45-degree field of view · color fundus image · 2352 x 1568 pixels: 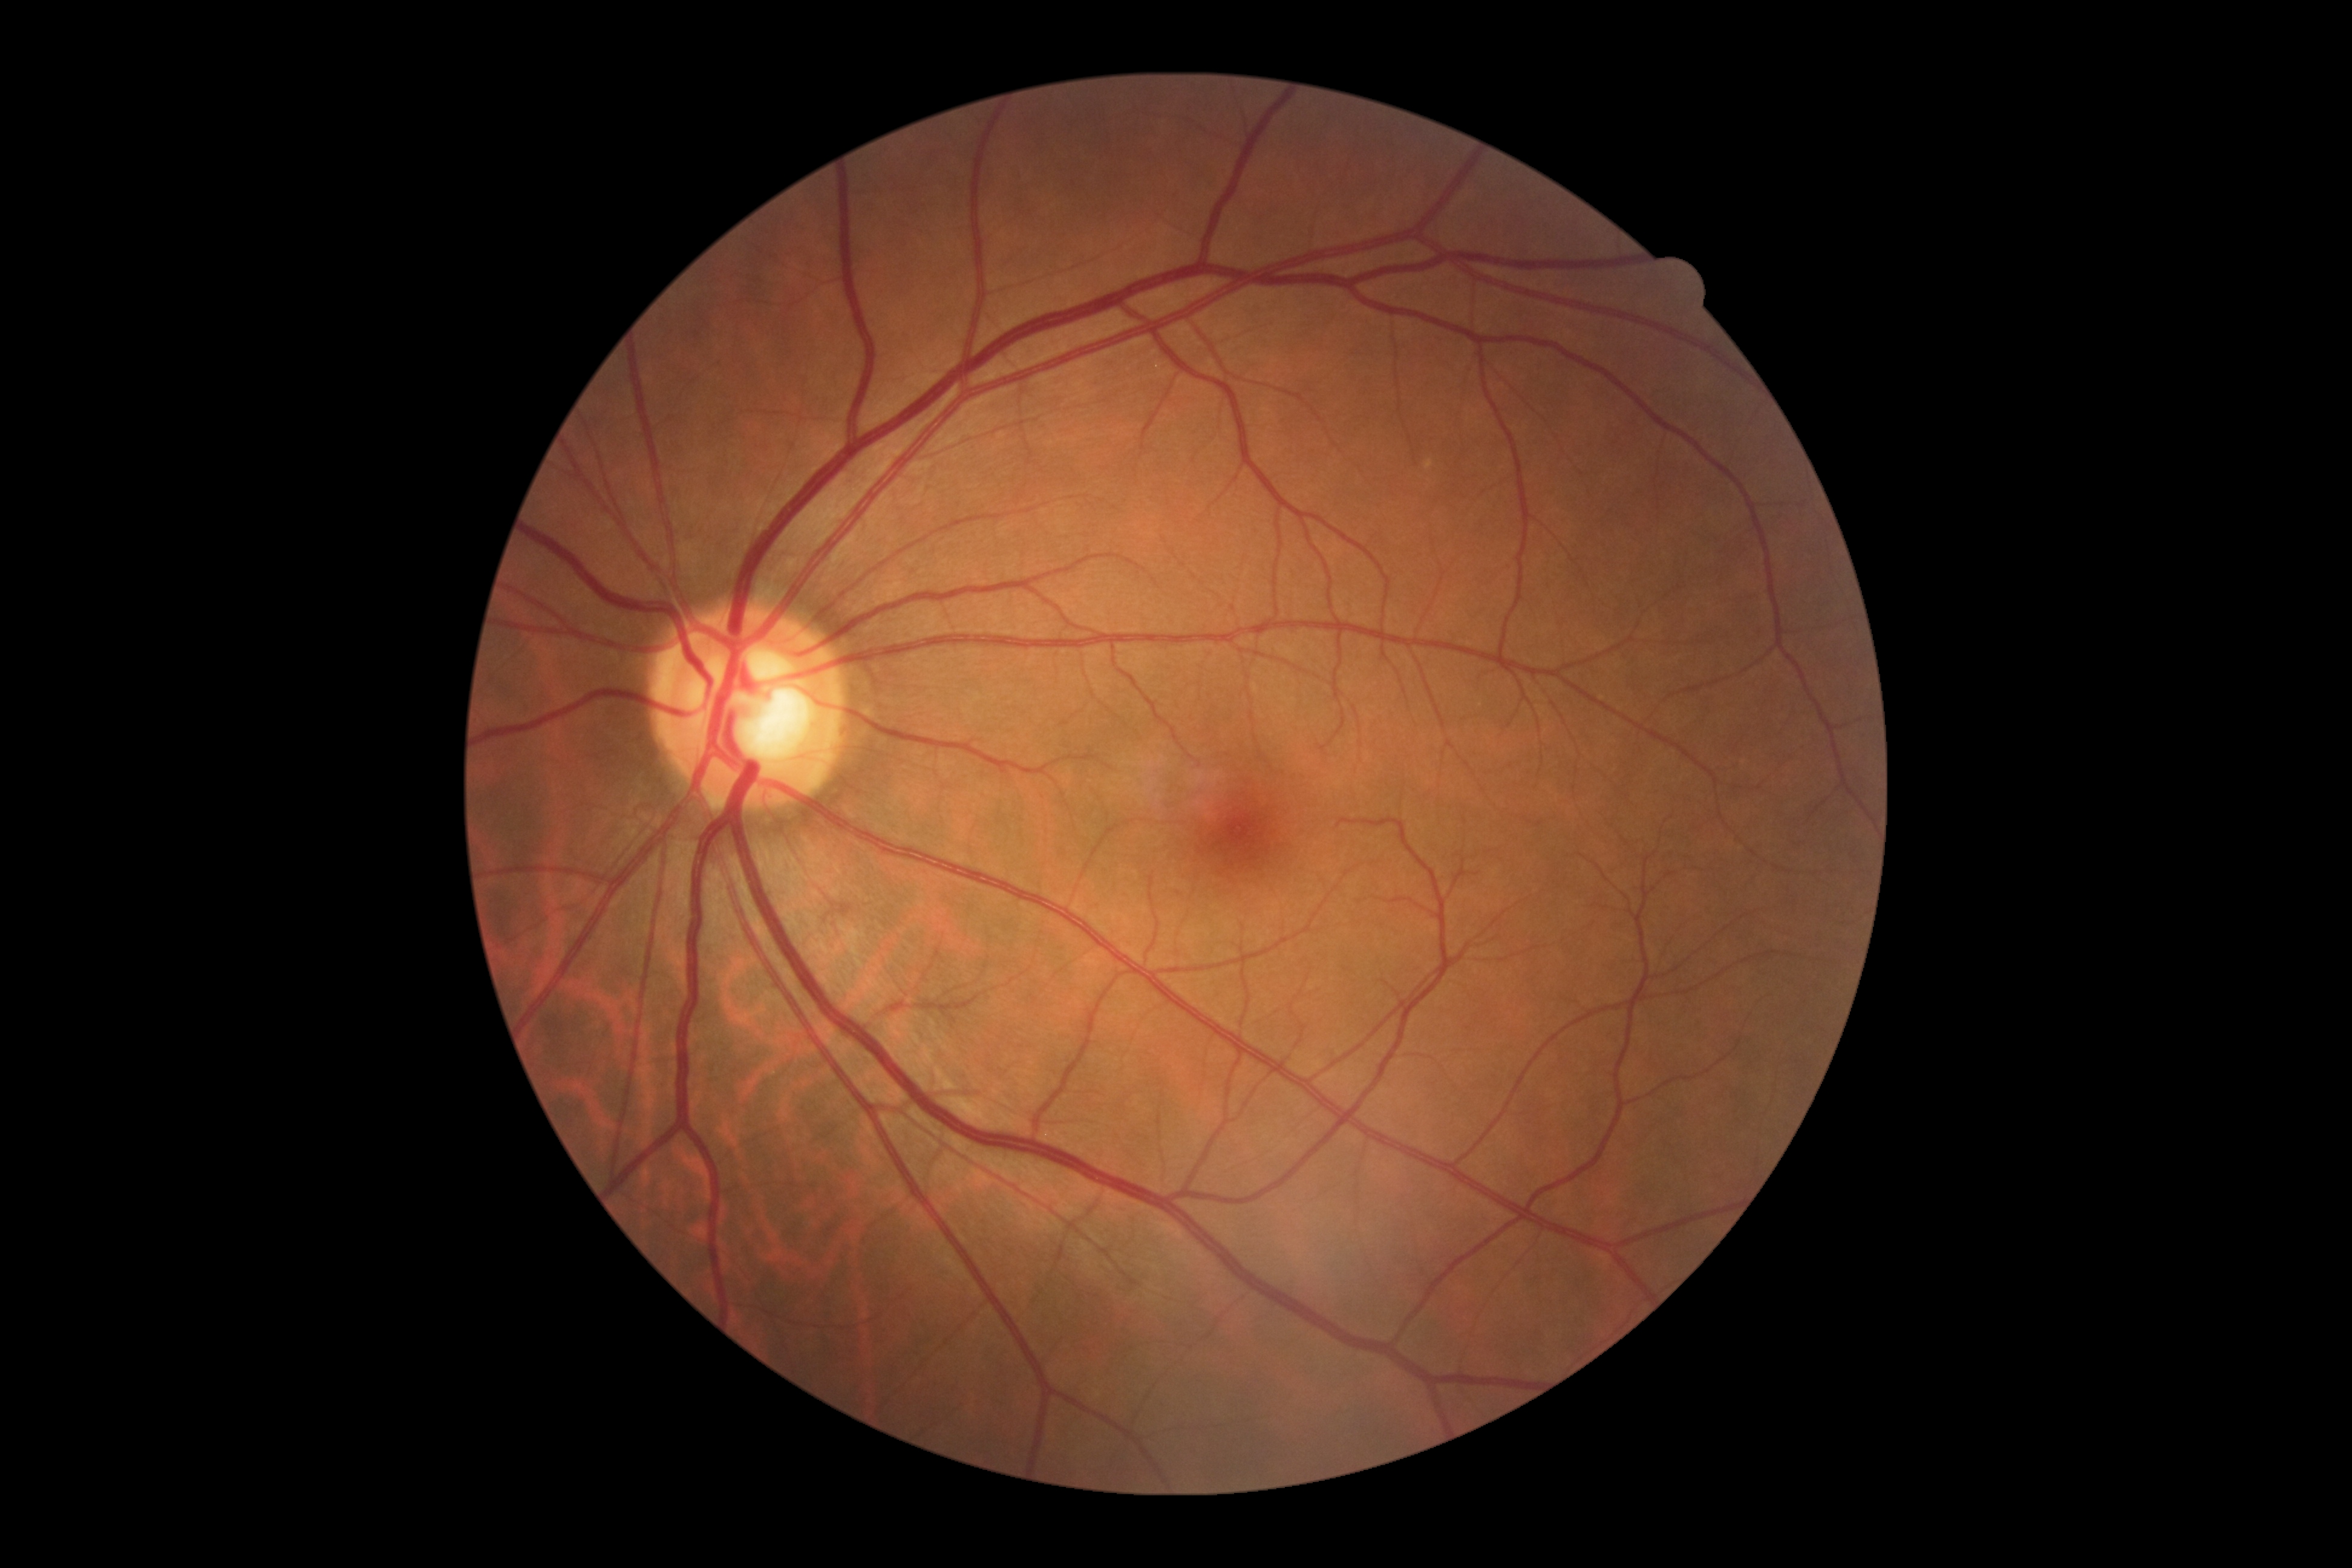

  dr_grade: no apparent diabetic retinopathy (0)